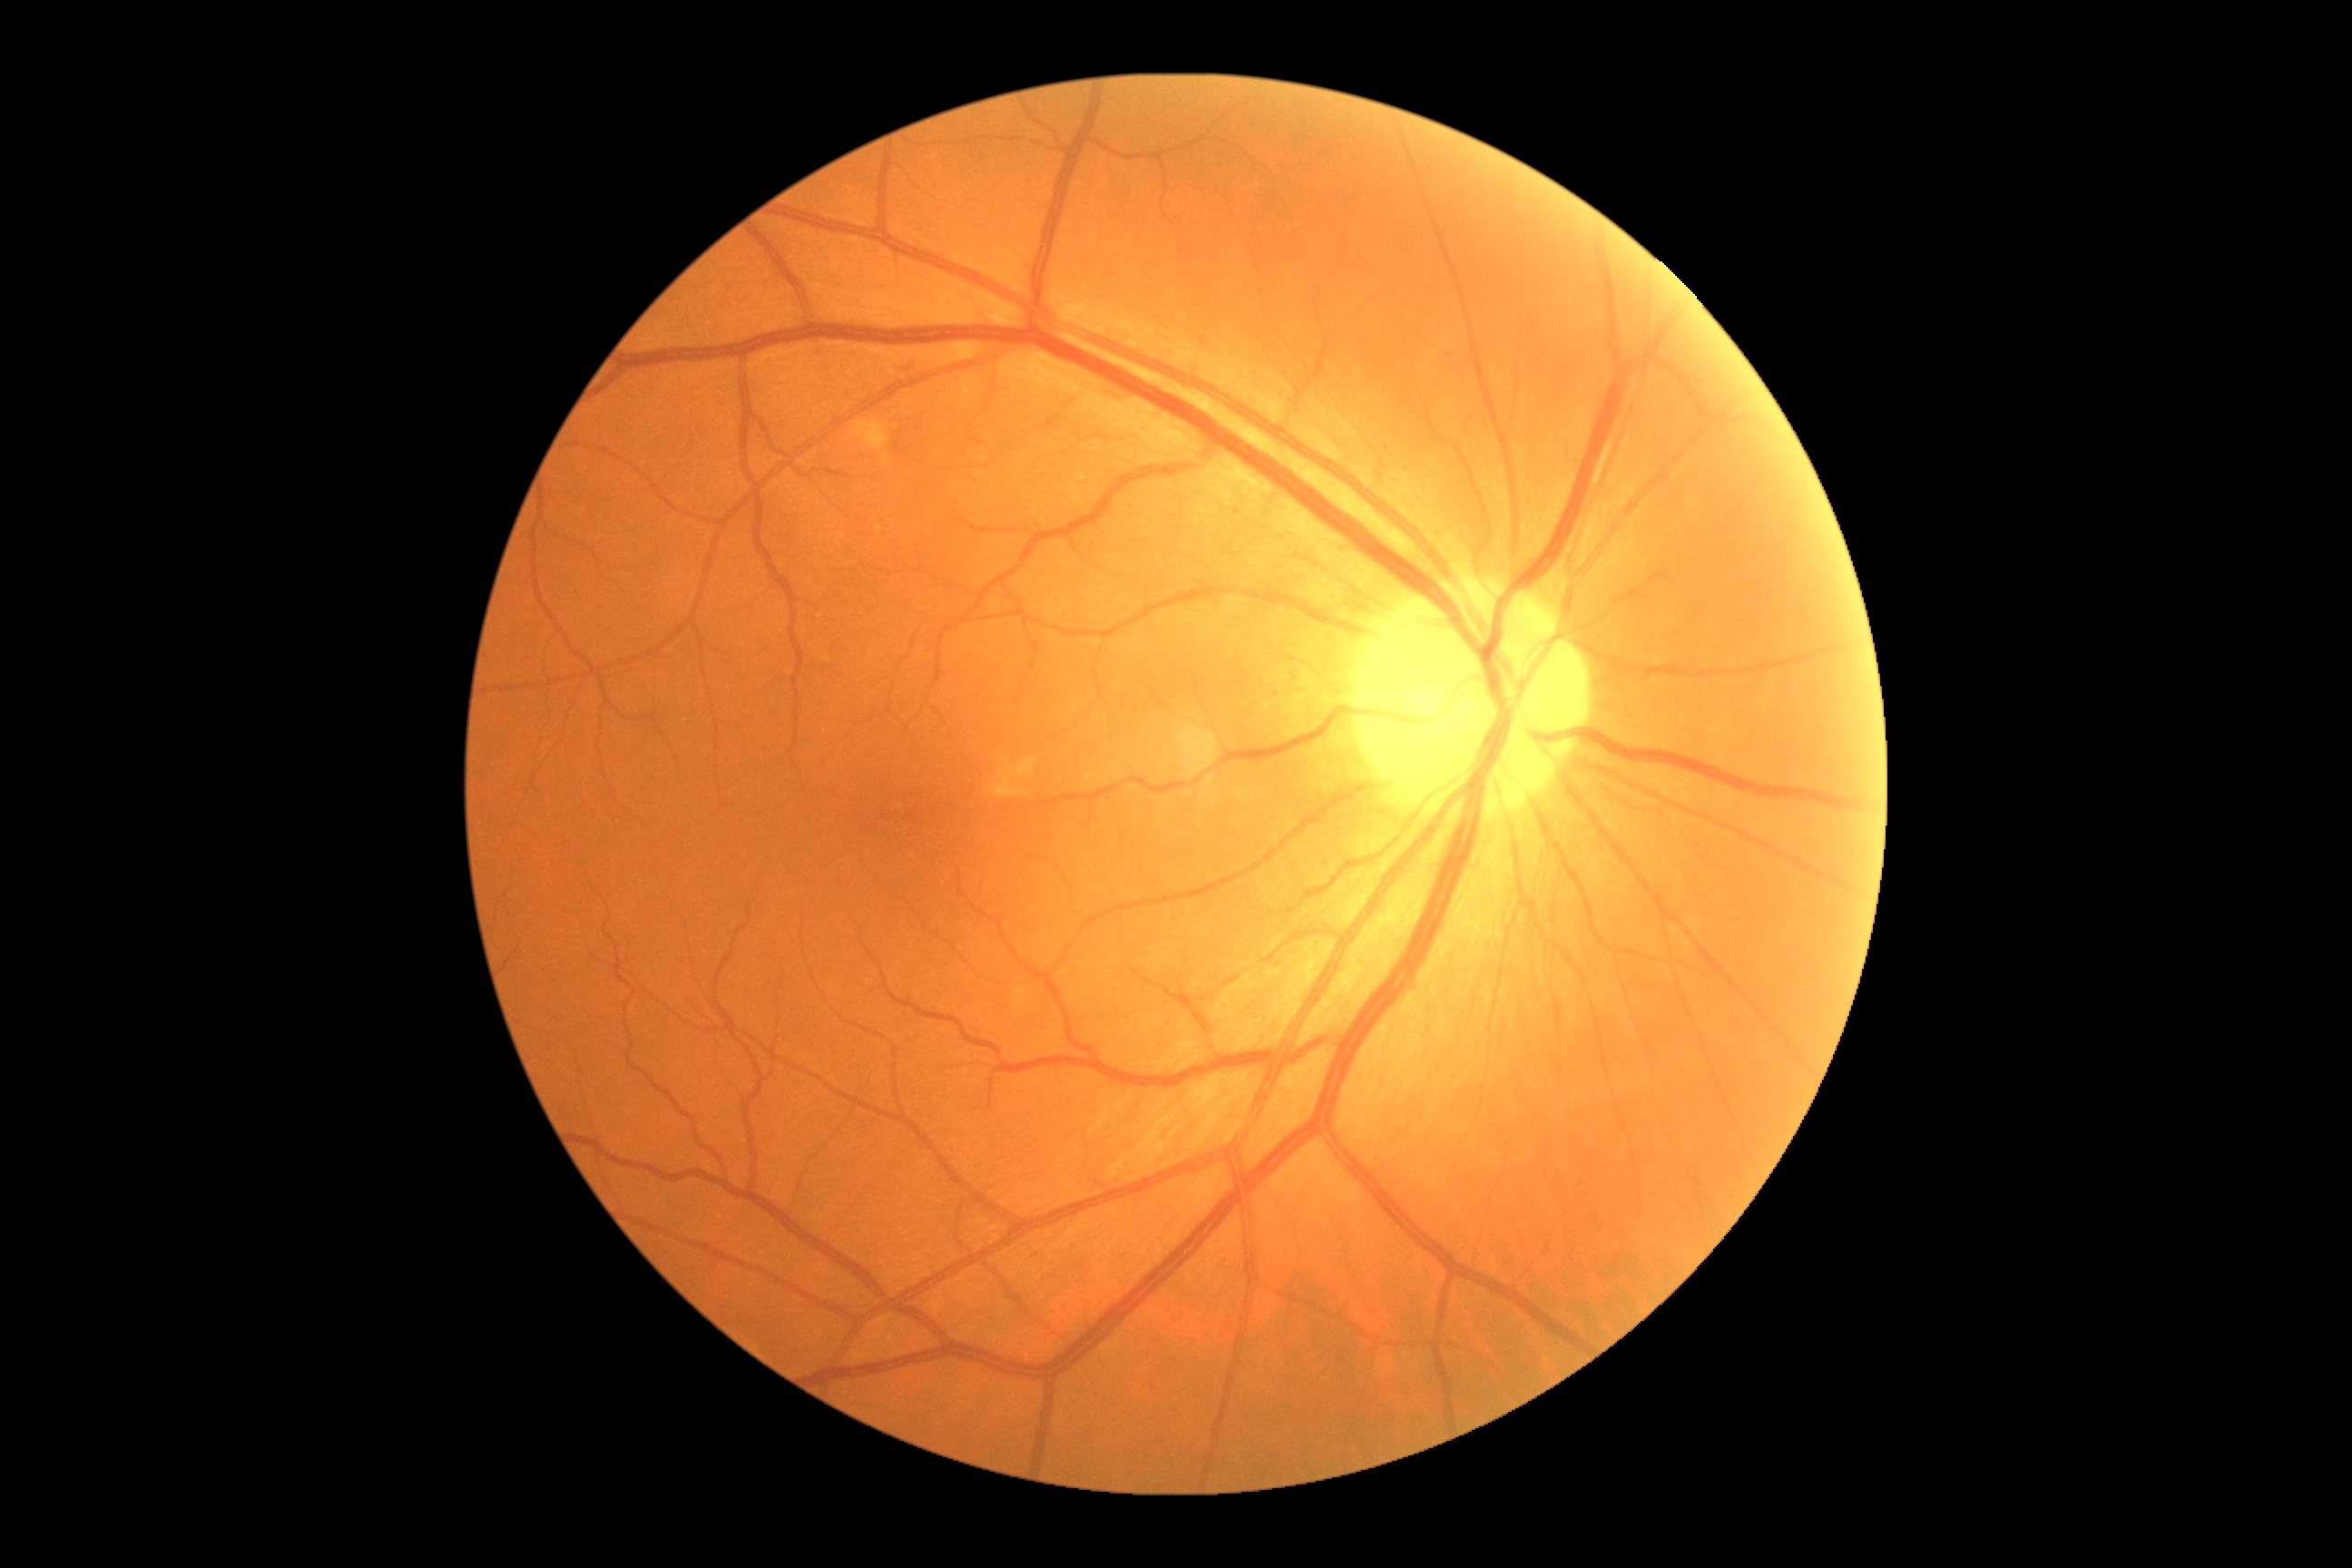 Diabetic retinopathy (DR) is 2/4.